Natus RetCam Envision, 130° FOV; pediatric wide-field fundus photograph
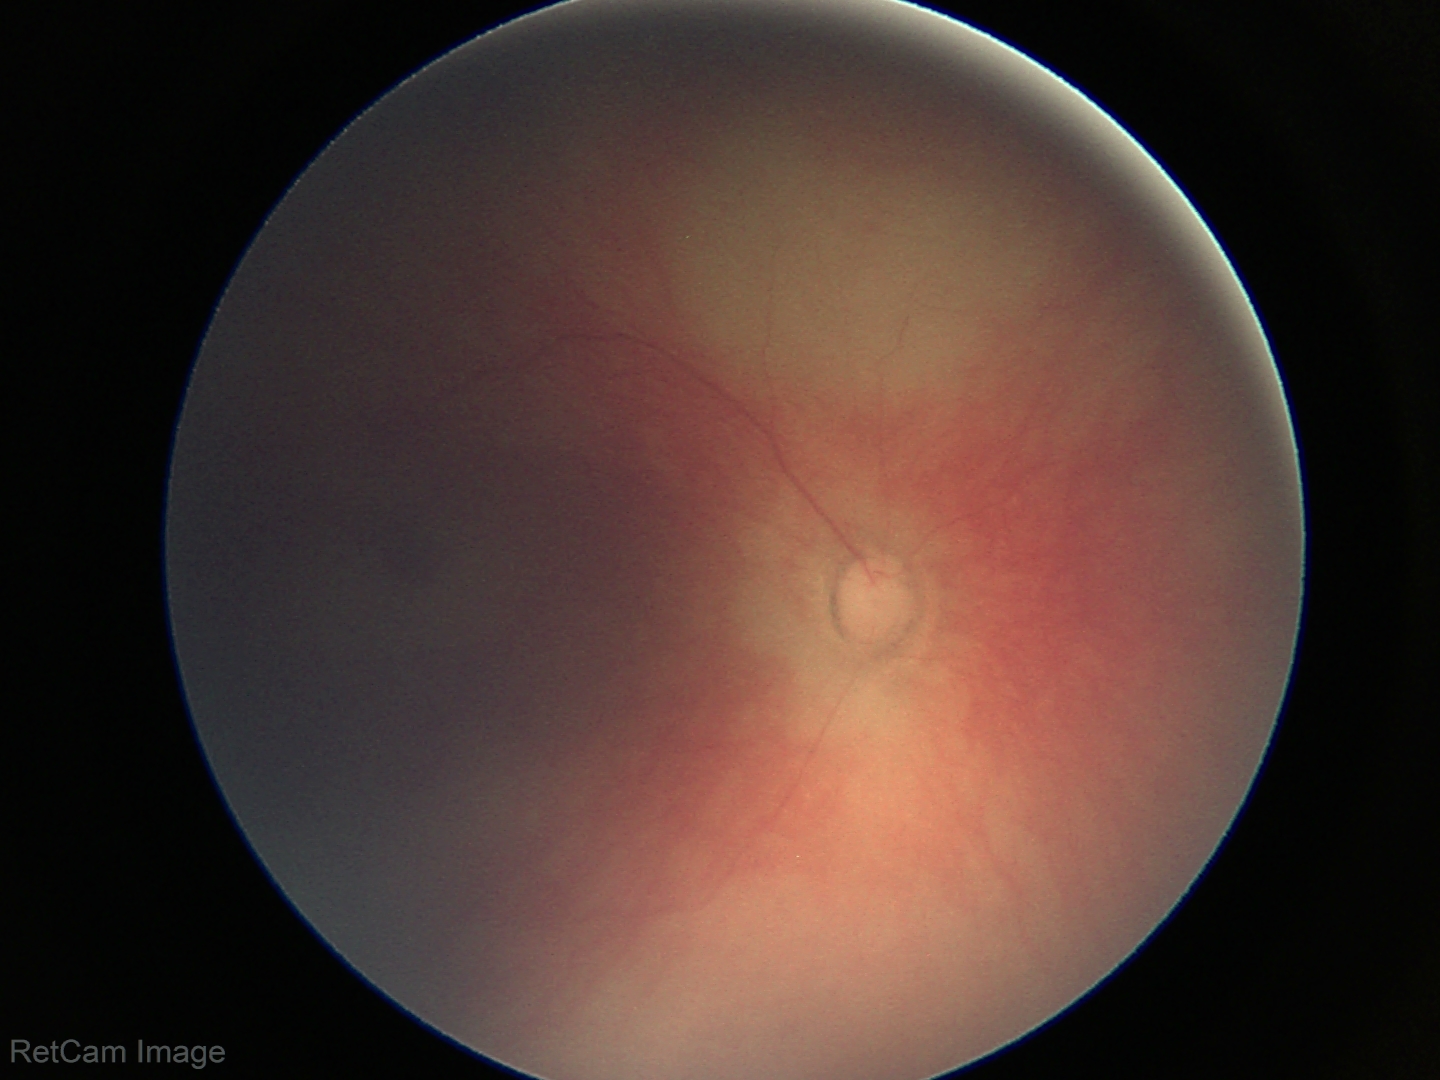

Q: What is the screening diagnosis?
A: no abnormal retinal findings